2352x1568. 45° field of view — 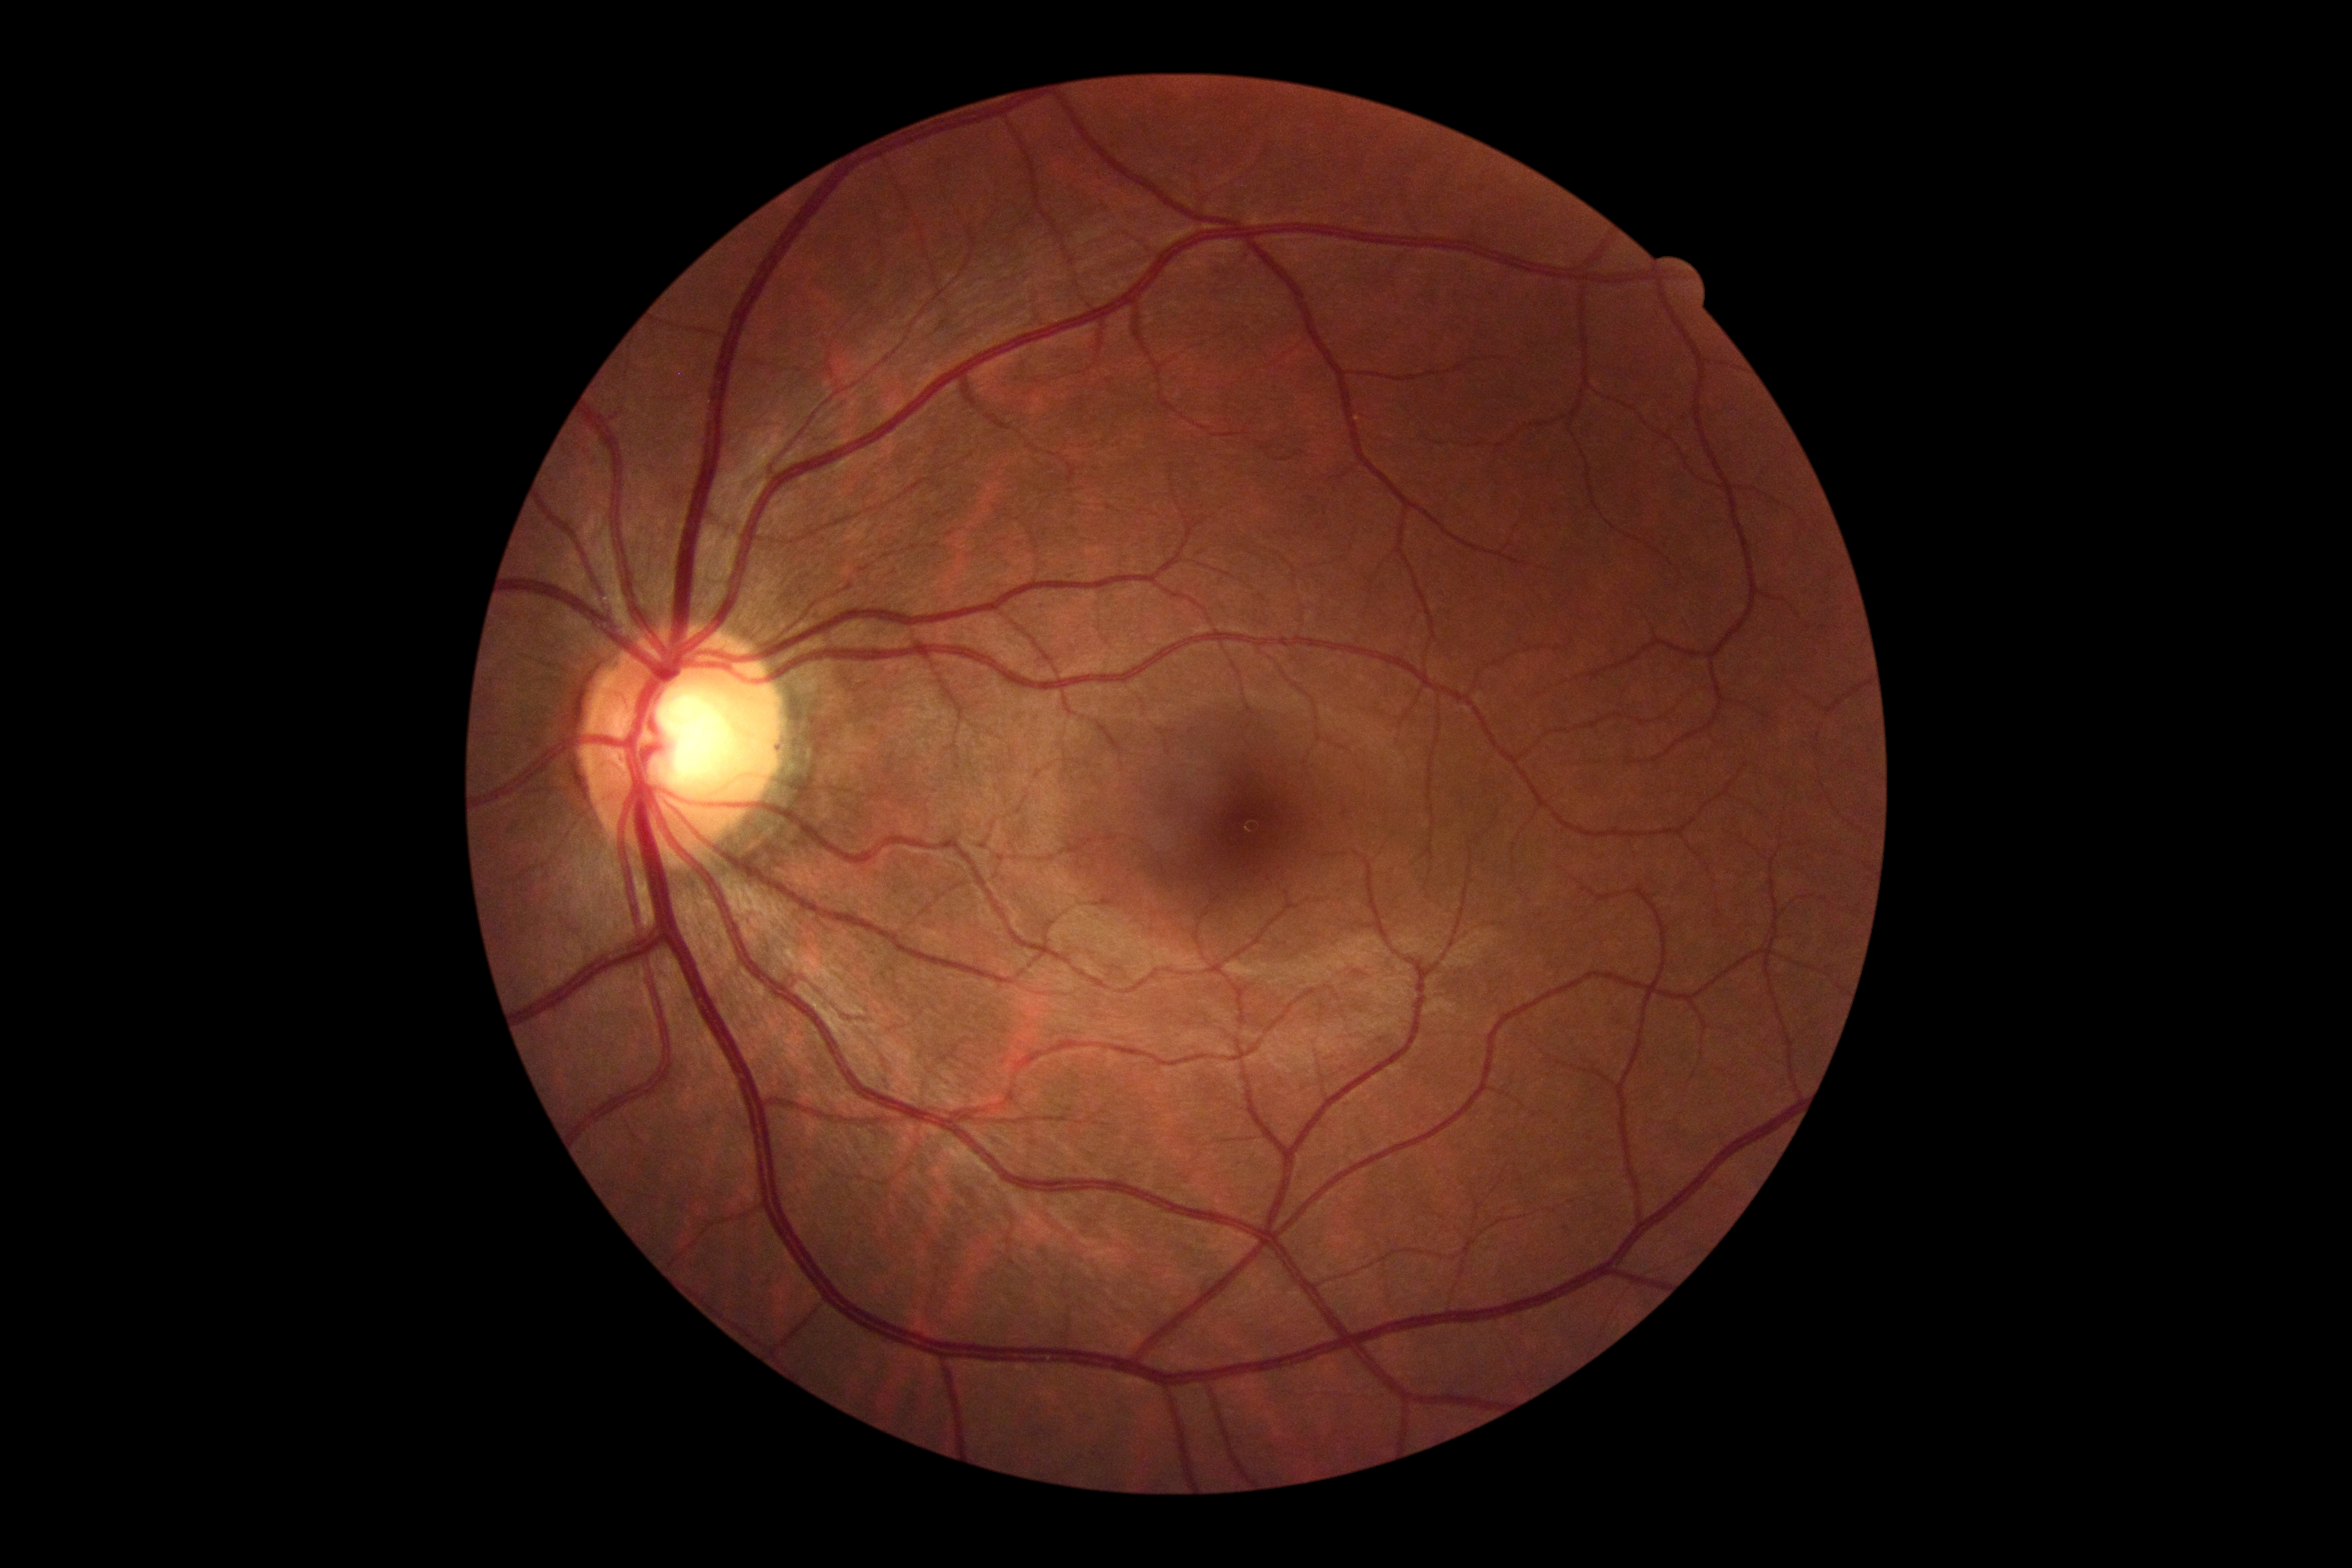

diabetic retinopathy (DR)@grade 0 (no apparent retinopathy).